Color fundus photograph:
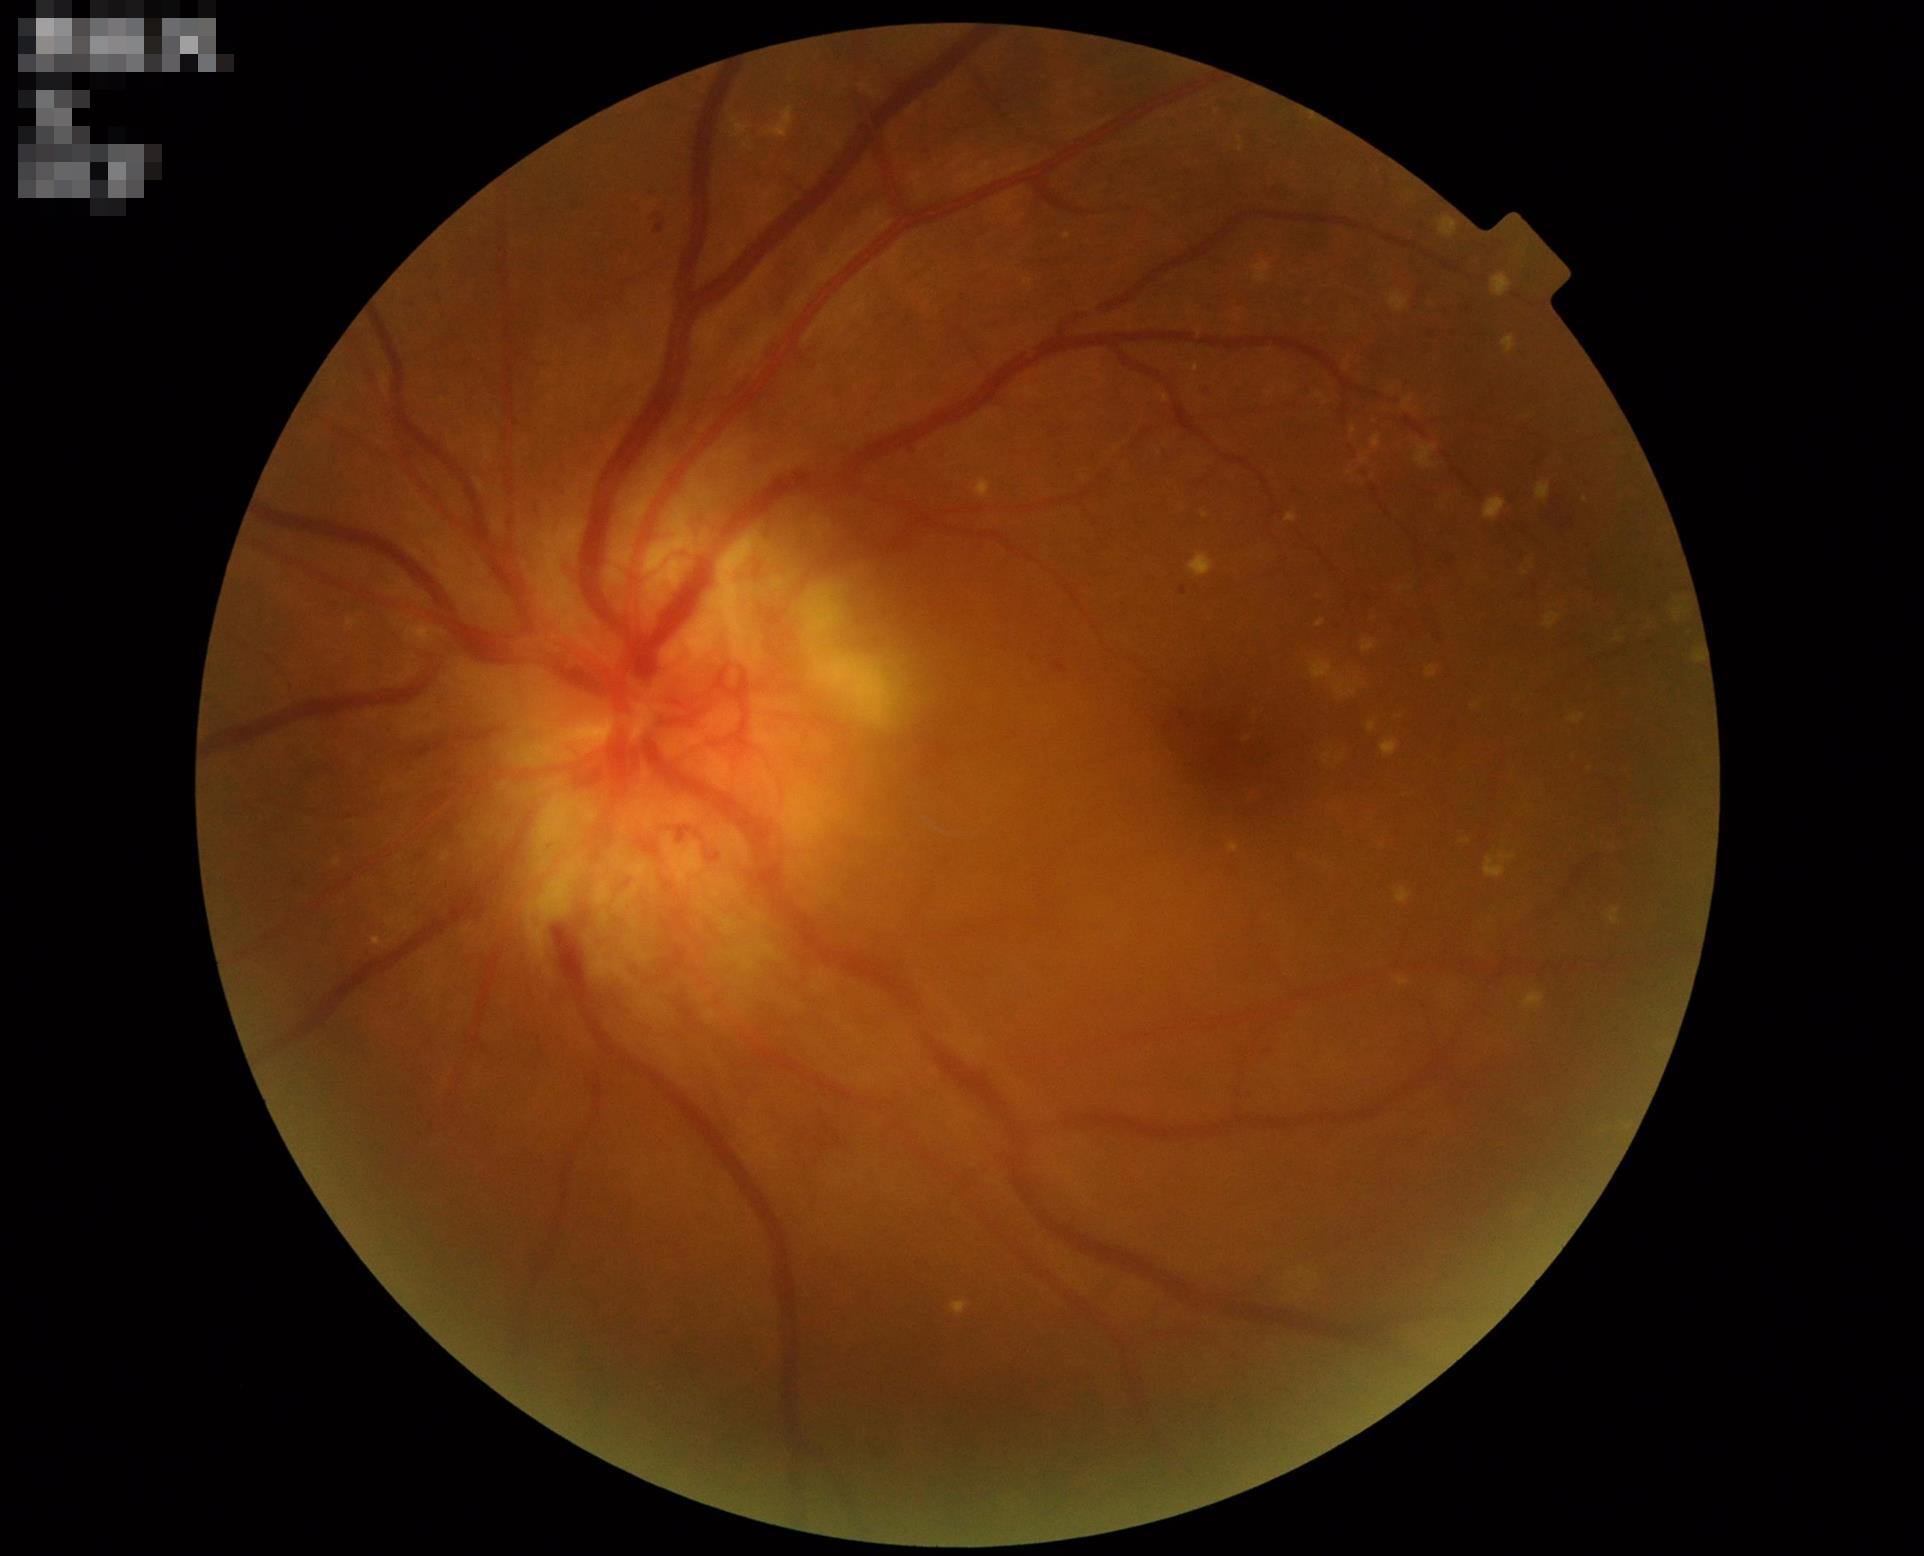

Focus: sharp.